45° FOV: 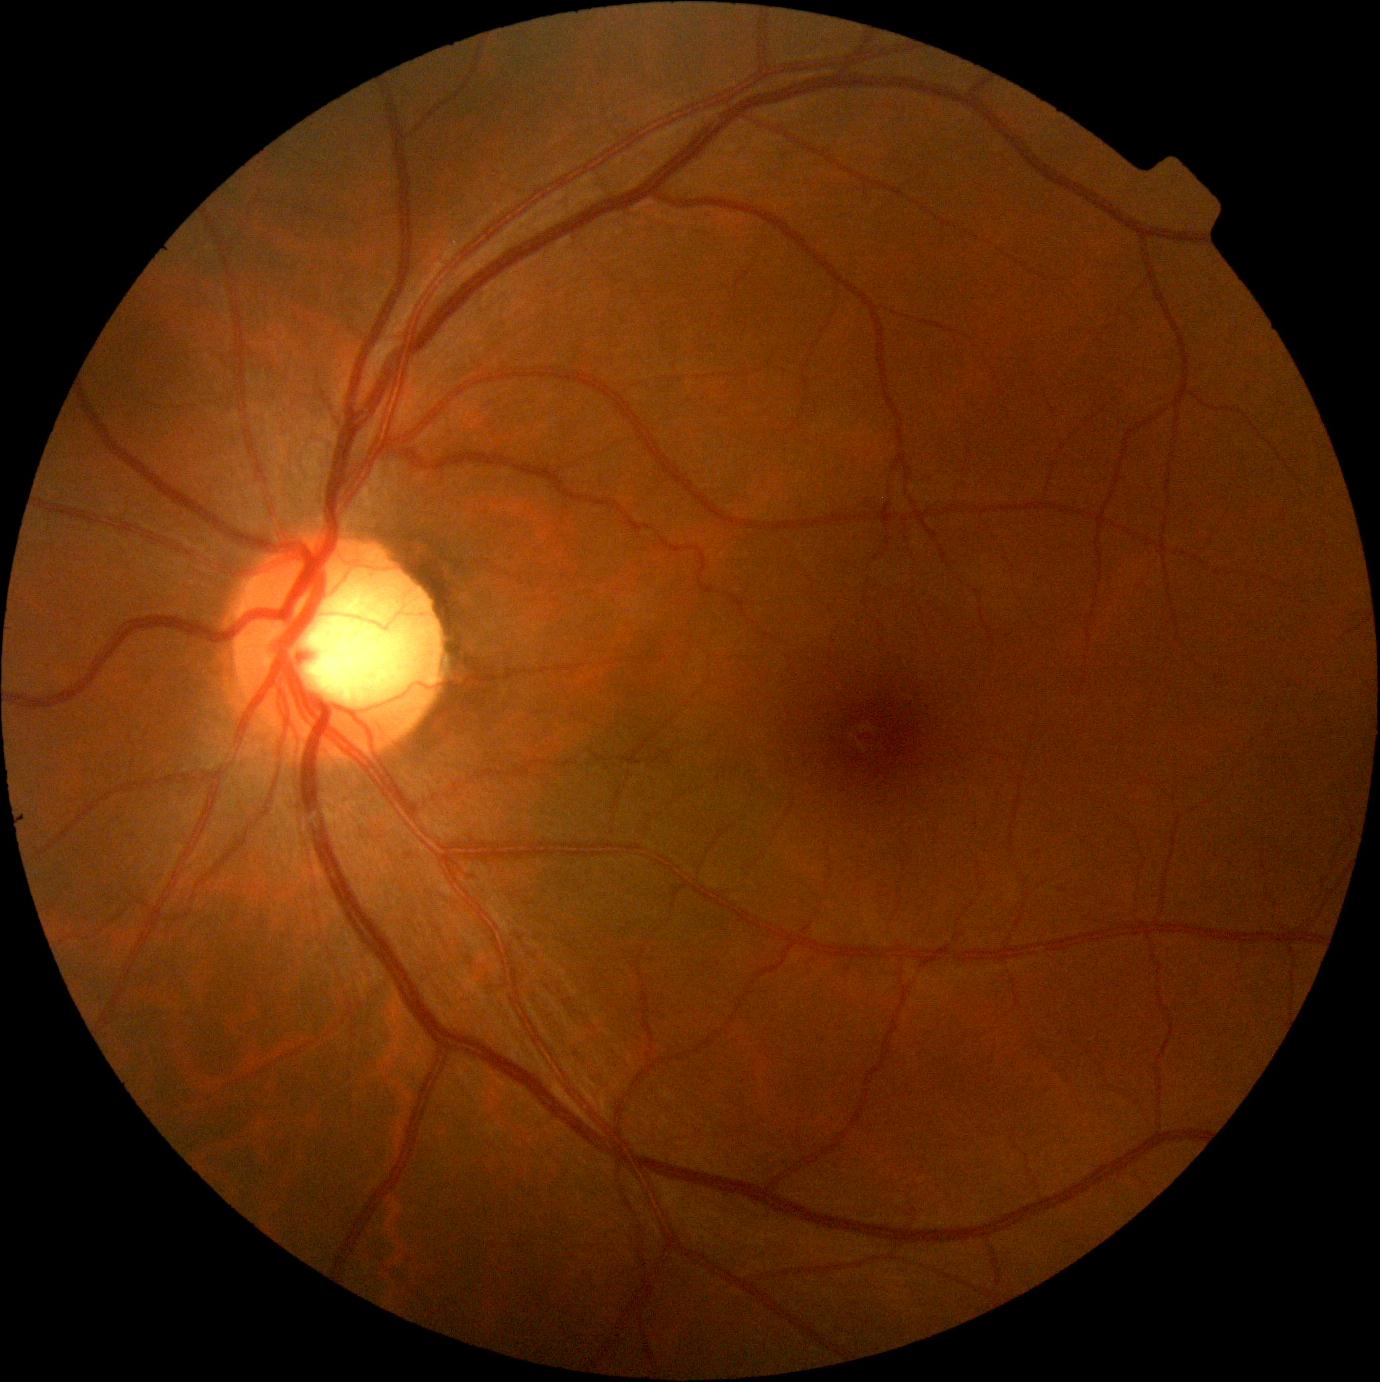 DR stage: grade 0 (no apparent retinopathy).